240 x 240 pixels: 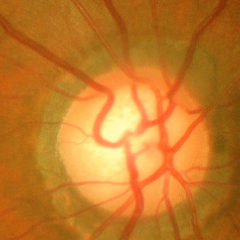
Glaucoma is present. Fundus appearance consistent with severe glaucomatous damage.